Captured on a Remidio FOP fundus camera.
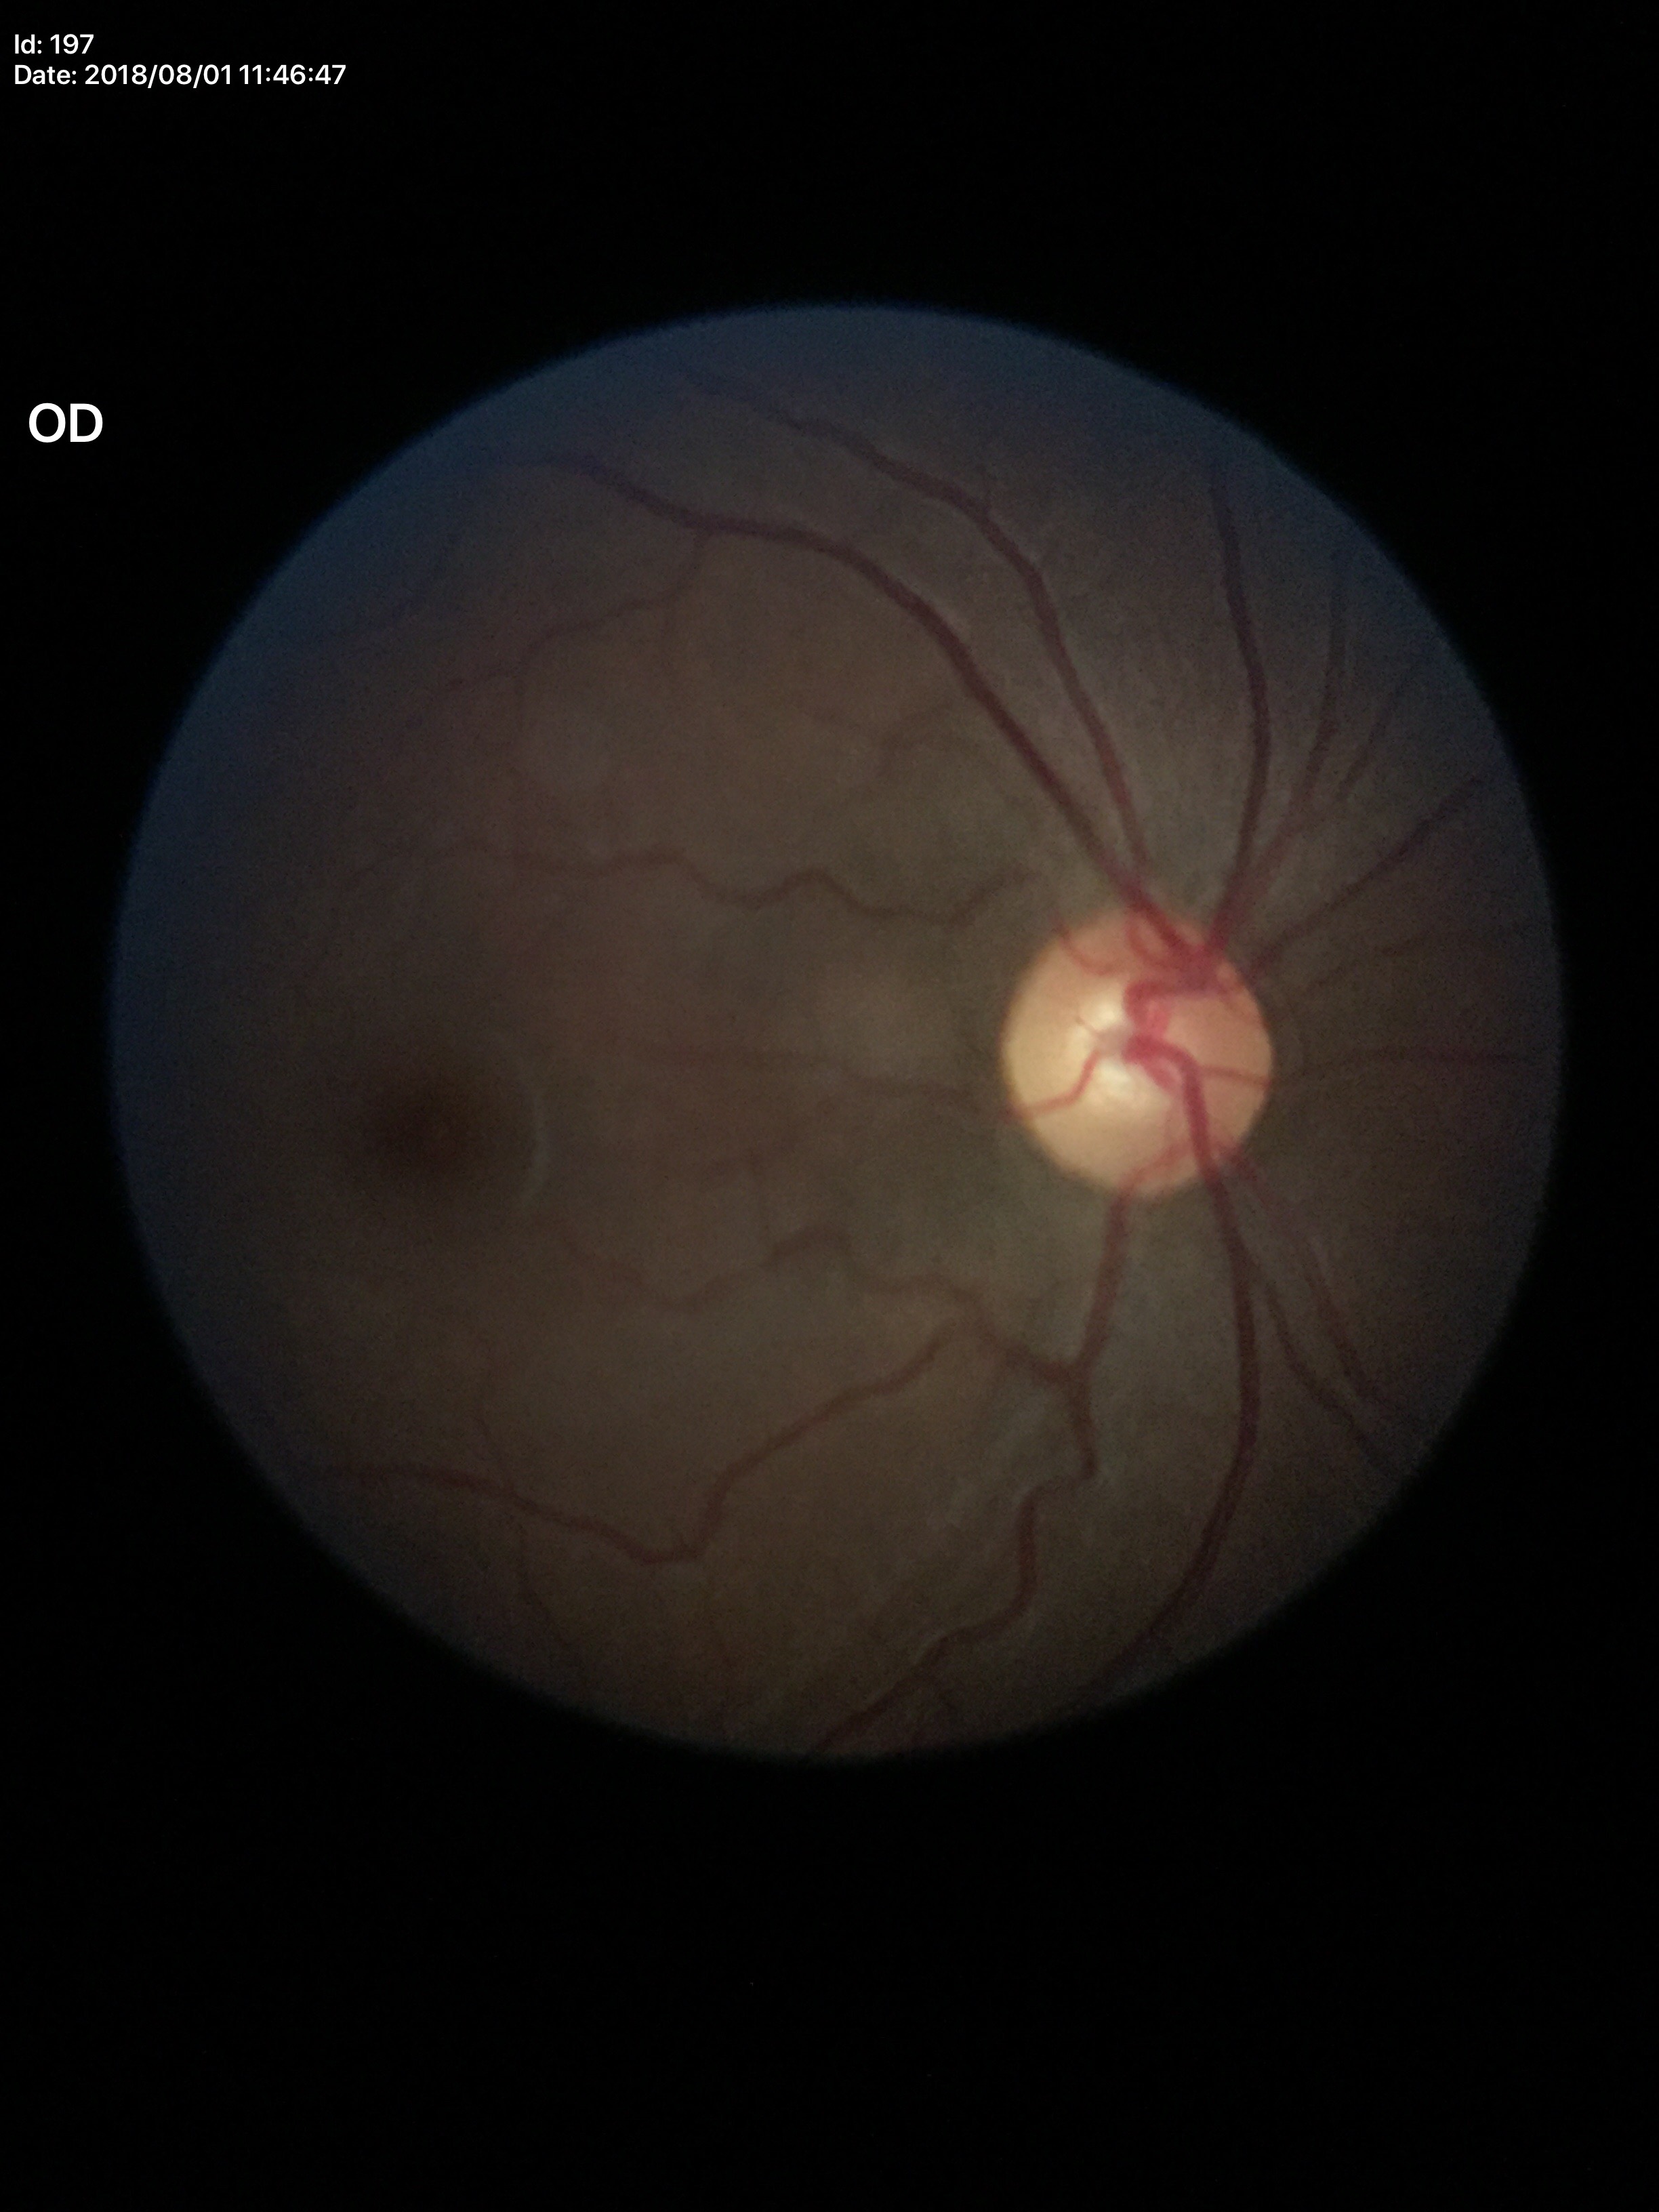
No evidence of glaucoma (2/5 graders called glaucoma suspect). Vertical cup-to-disc ratio is 0.56. Horizontal CDR of 0.55.